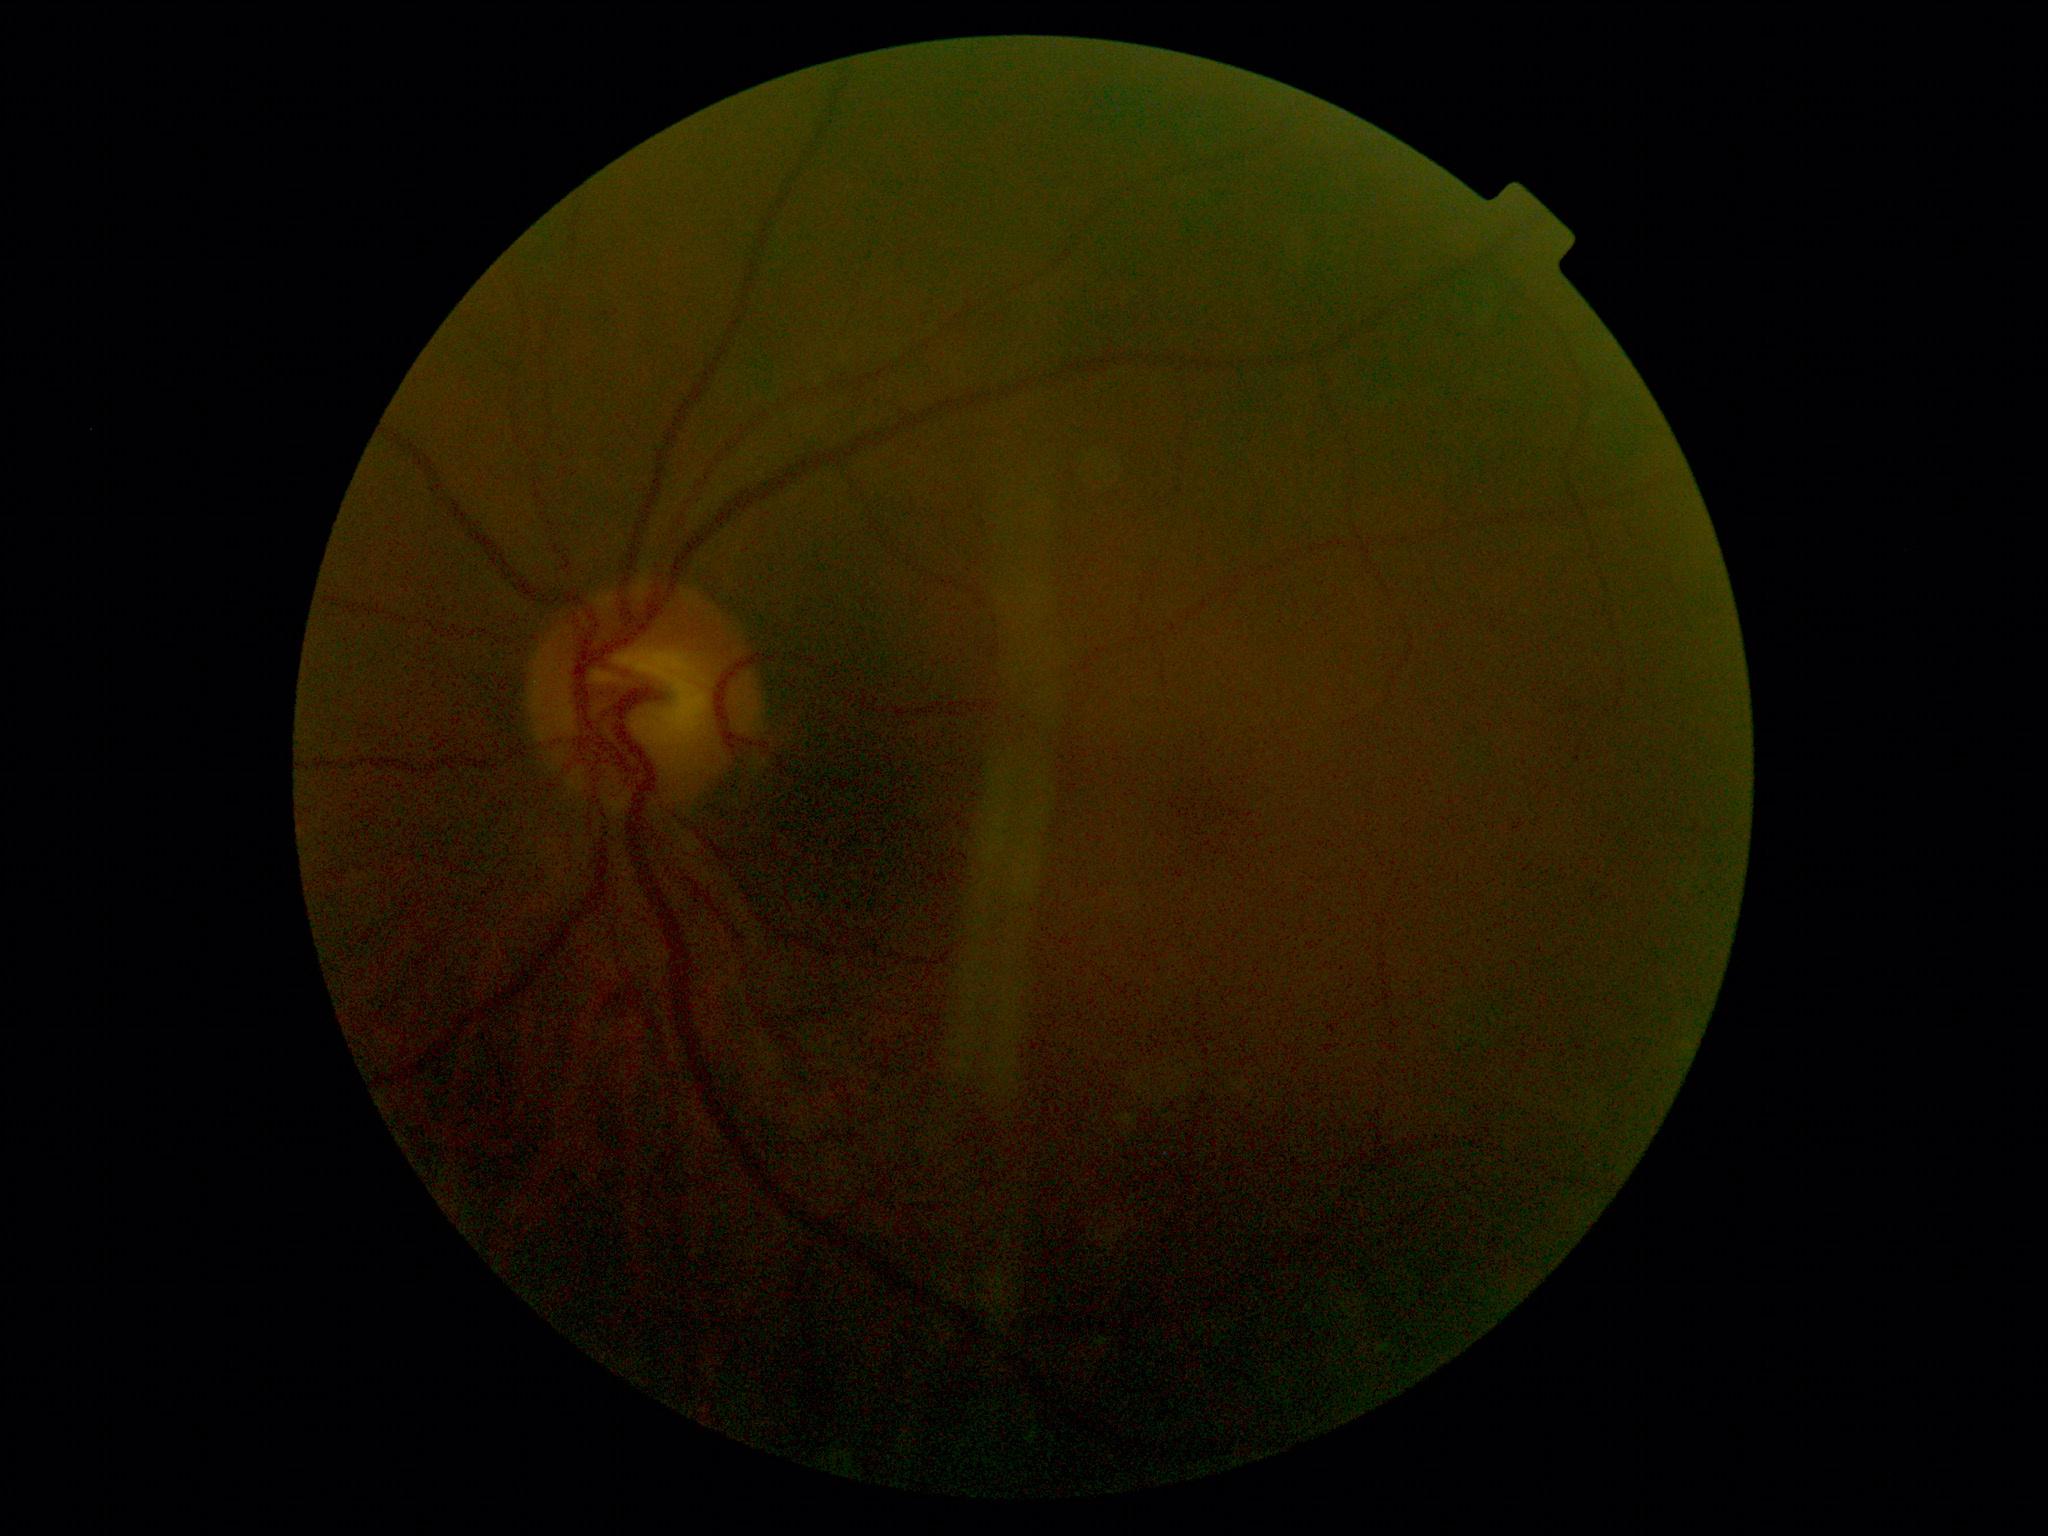 retinopathy: no apparent retinopathy (grade 0).